Modified Davis classification — 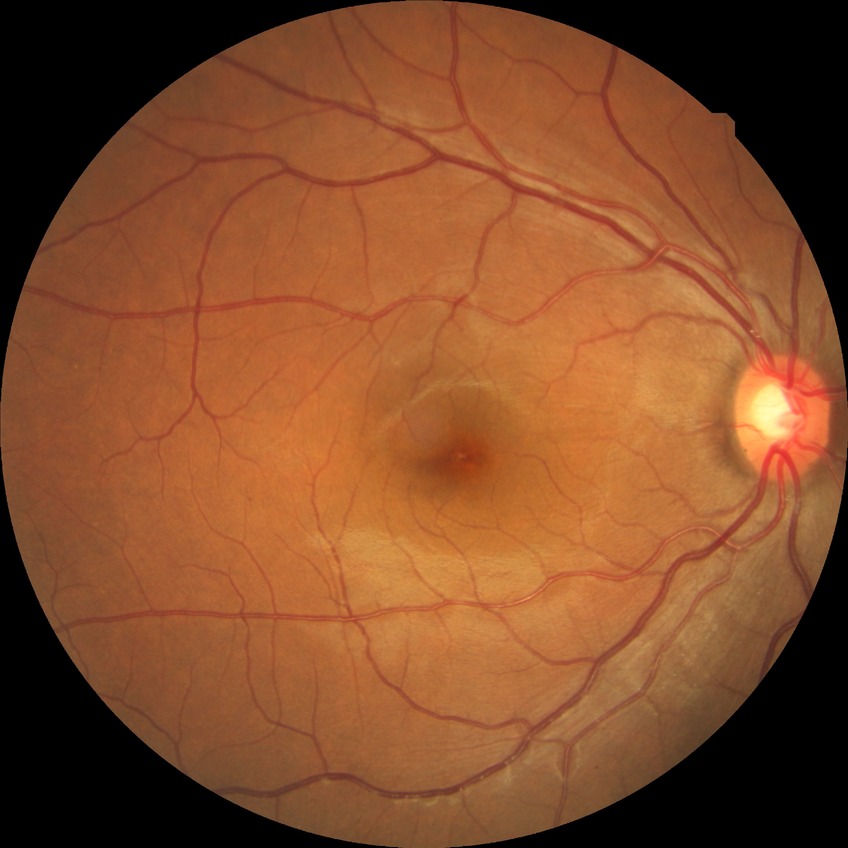

diabetic retinopathy (DR): NDR (no diabetic retinopathy)